Davis DR grading.
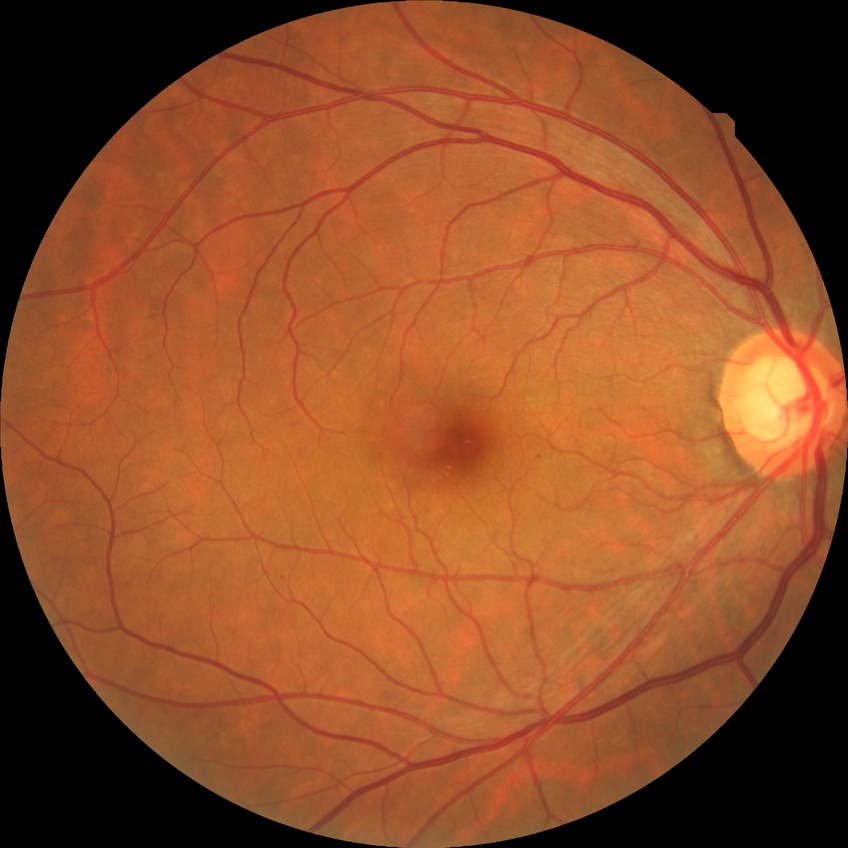

DR severity is SDR.